CFP. 2352x1568 — 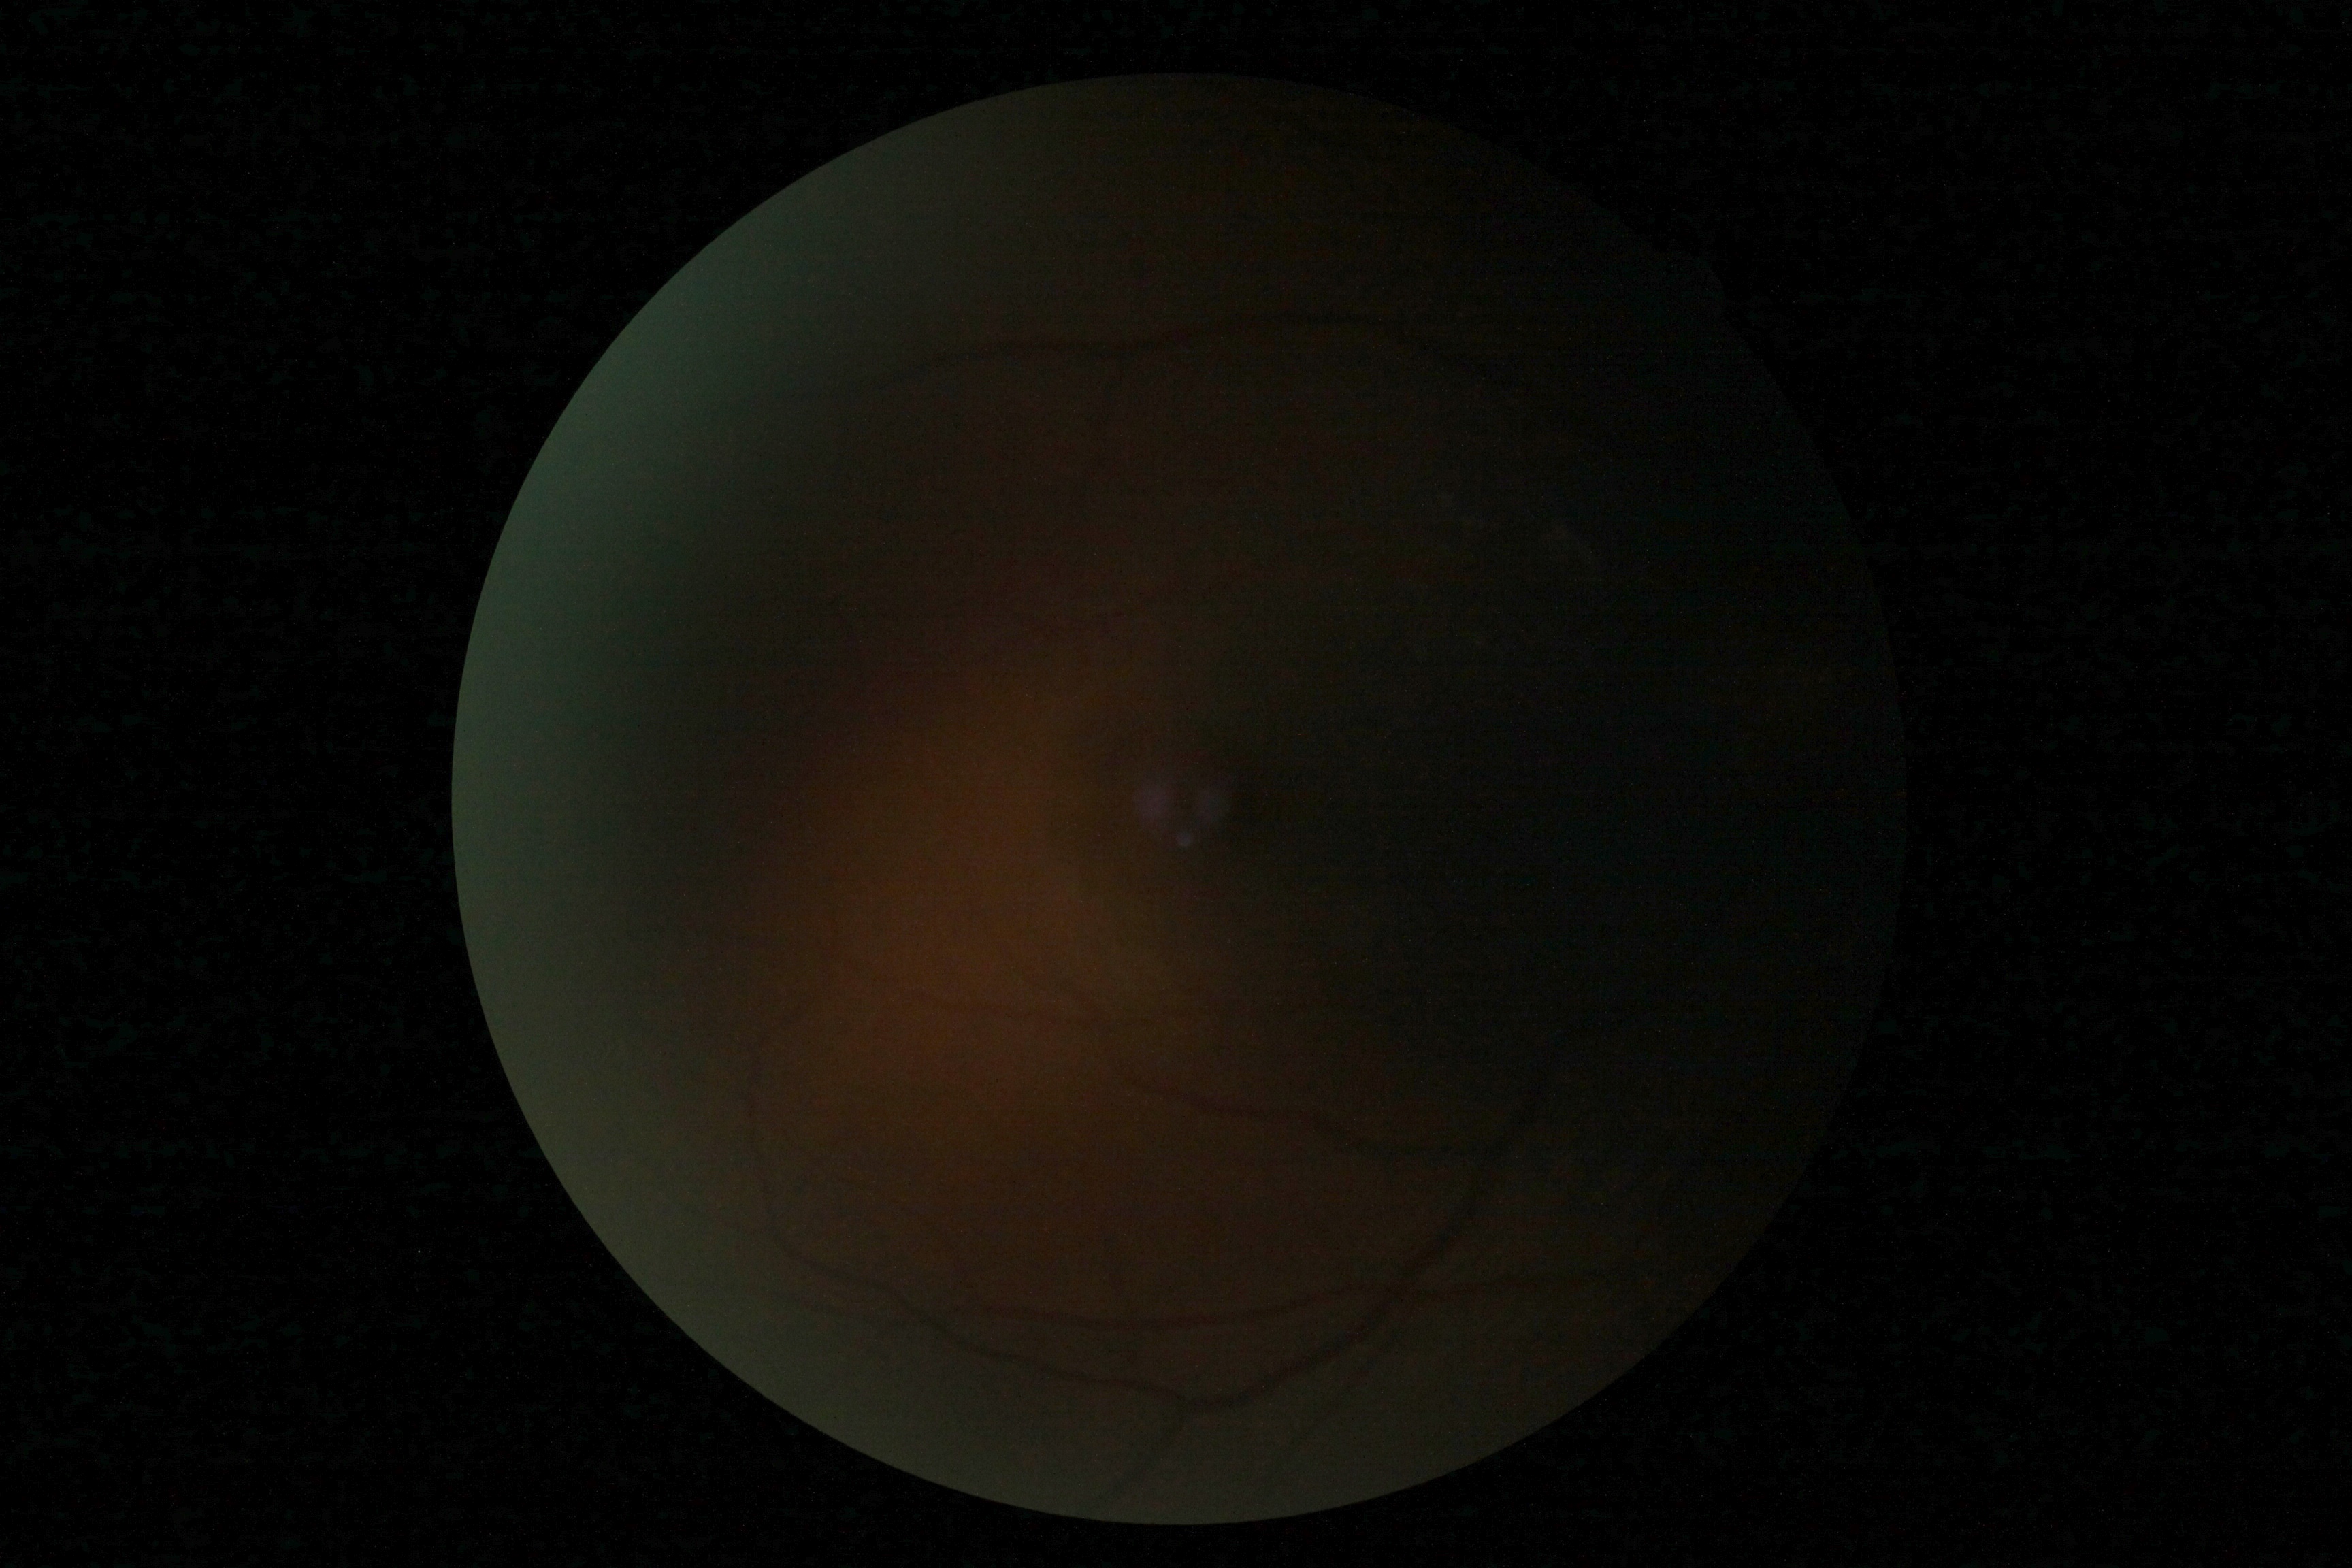 Retinopathy grade is ungradable.